Acquired with a Nidek AFC-330; optic disc region crop — 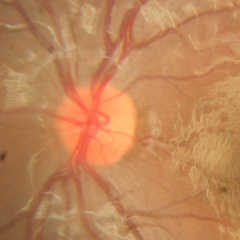 Q: What stage of glaucoma is present?
A: No glaucoma.